45° FOV — 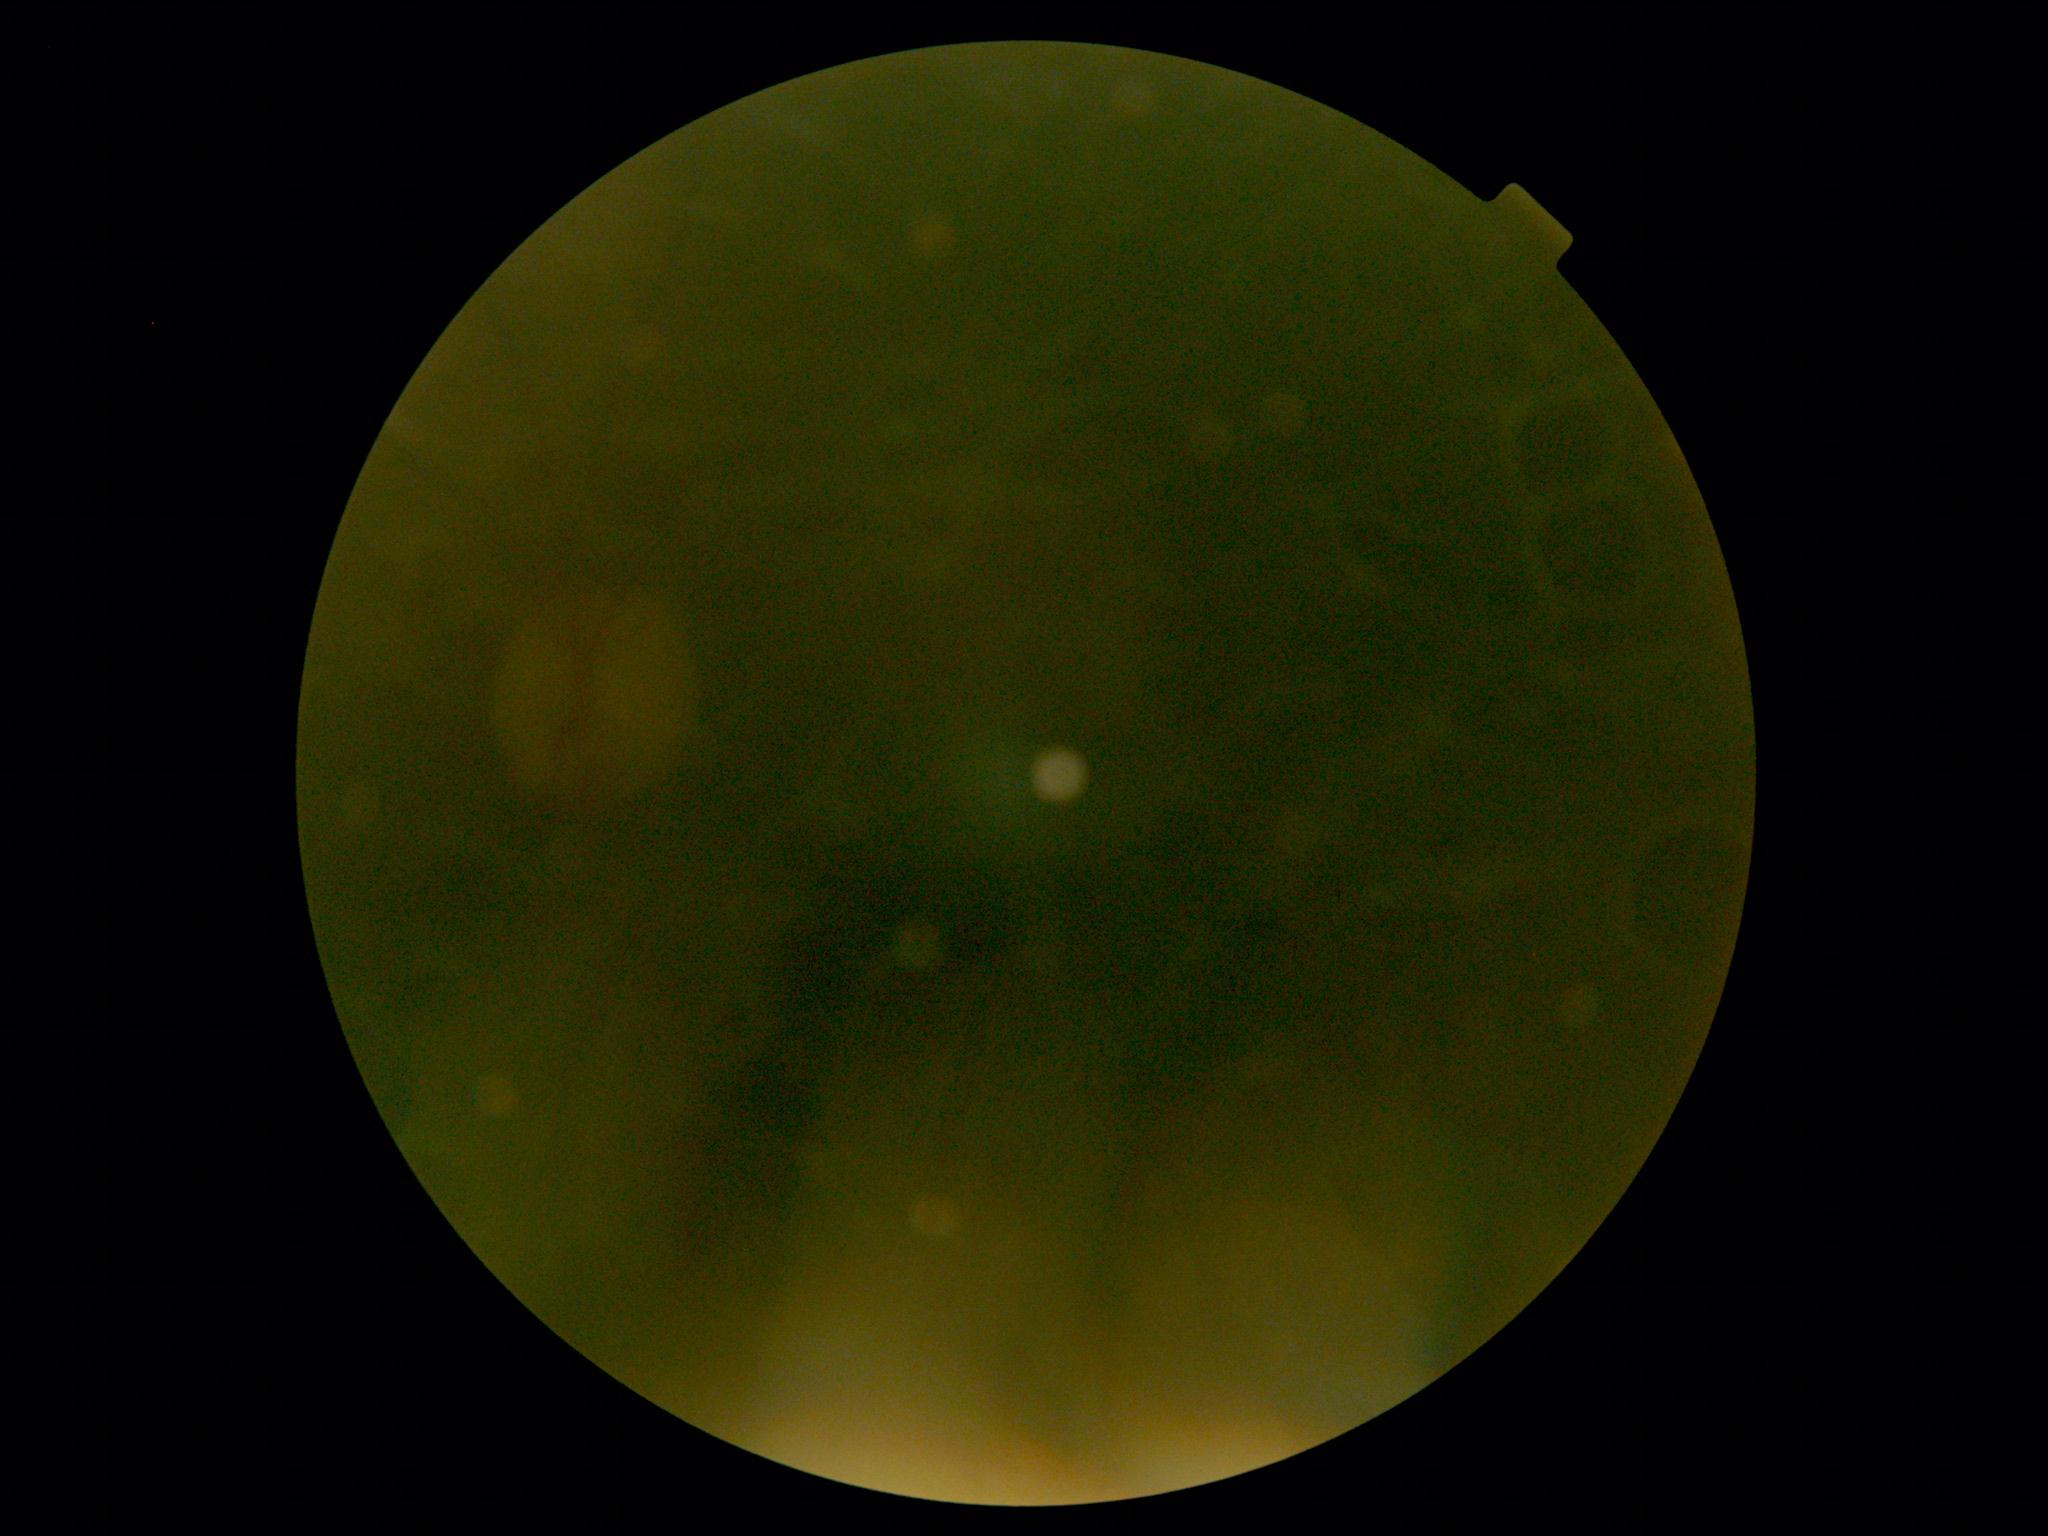 diabetic retinopathy=ungradable, image quality=too poor for DR grading.